Captured on a Topcon TRC-NW8 fundus camera. Macula-centered field. Dilated-pupil acquisition:
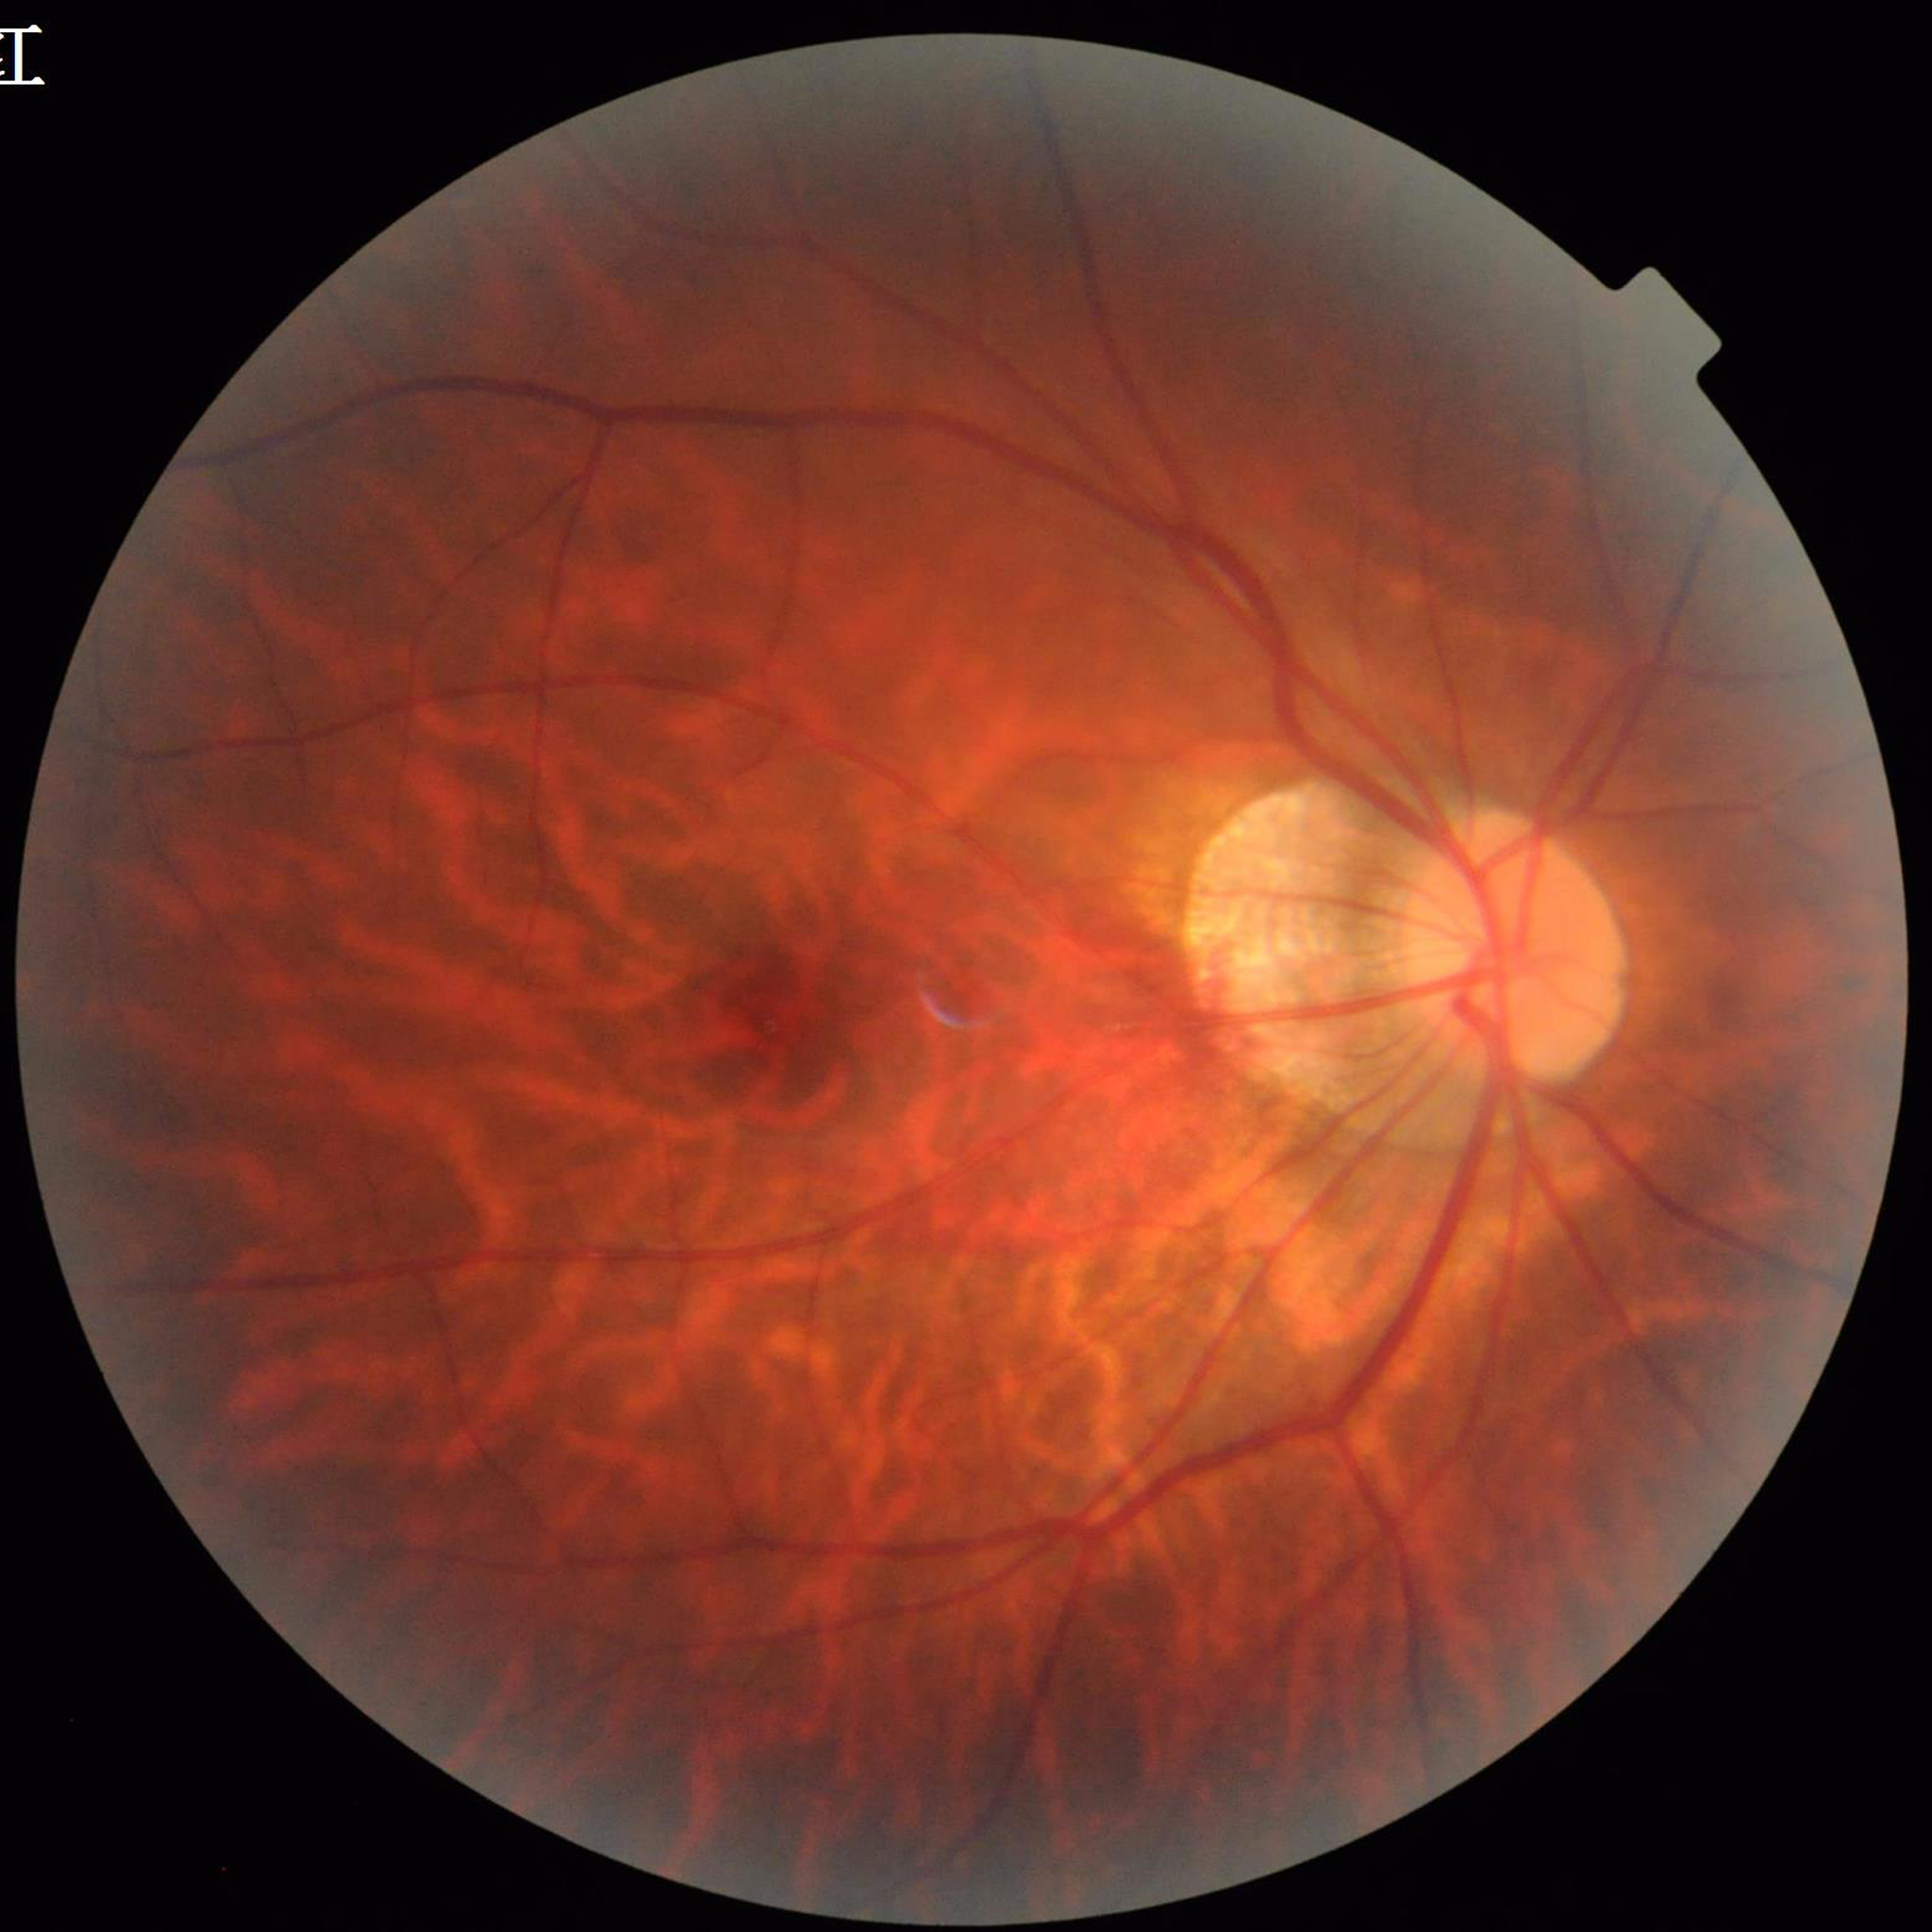

  image_quality: no concerns identified
  diagnosis: age-related macular degeneration